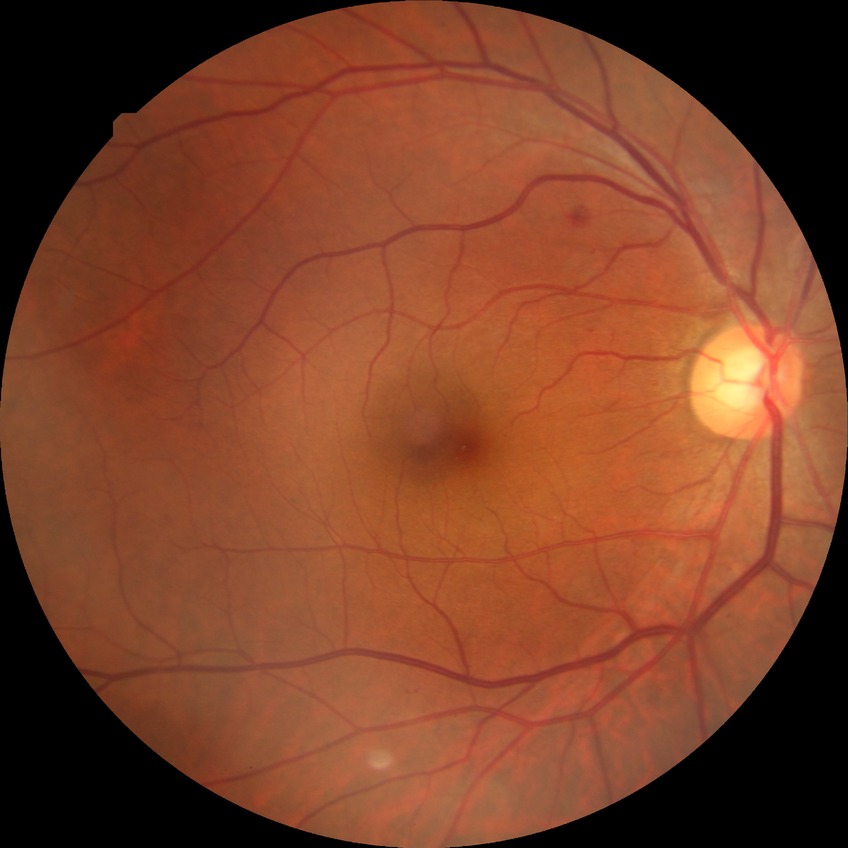
diabetic retinopathy severity: simple diabetic retinopathy.